Clarity RetCam 3, 130° FOV · 640x480 · RetCam wide-field infant fundus image:
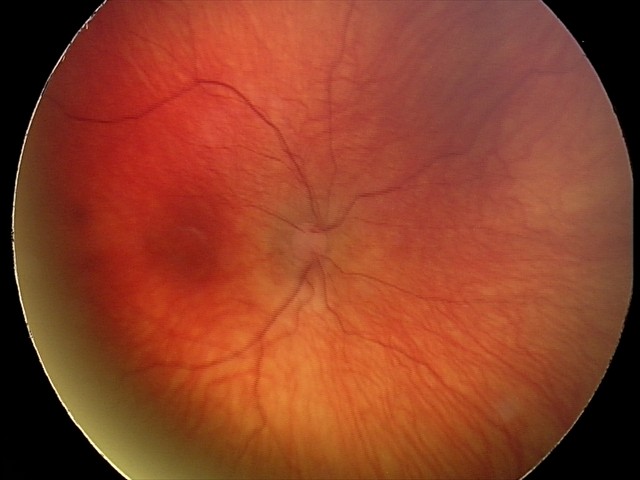 Screening examination consistent with status post ROP. No plus disease.